50° field of view.
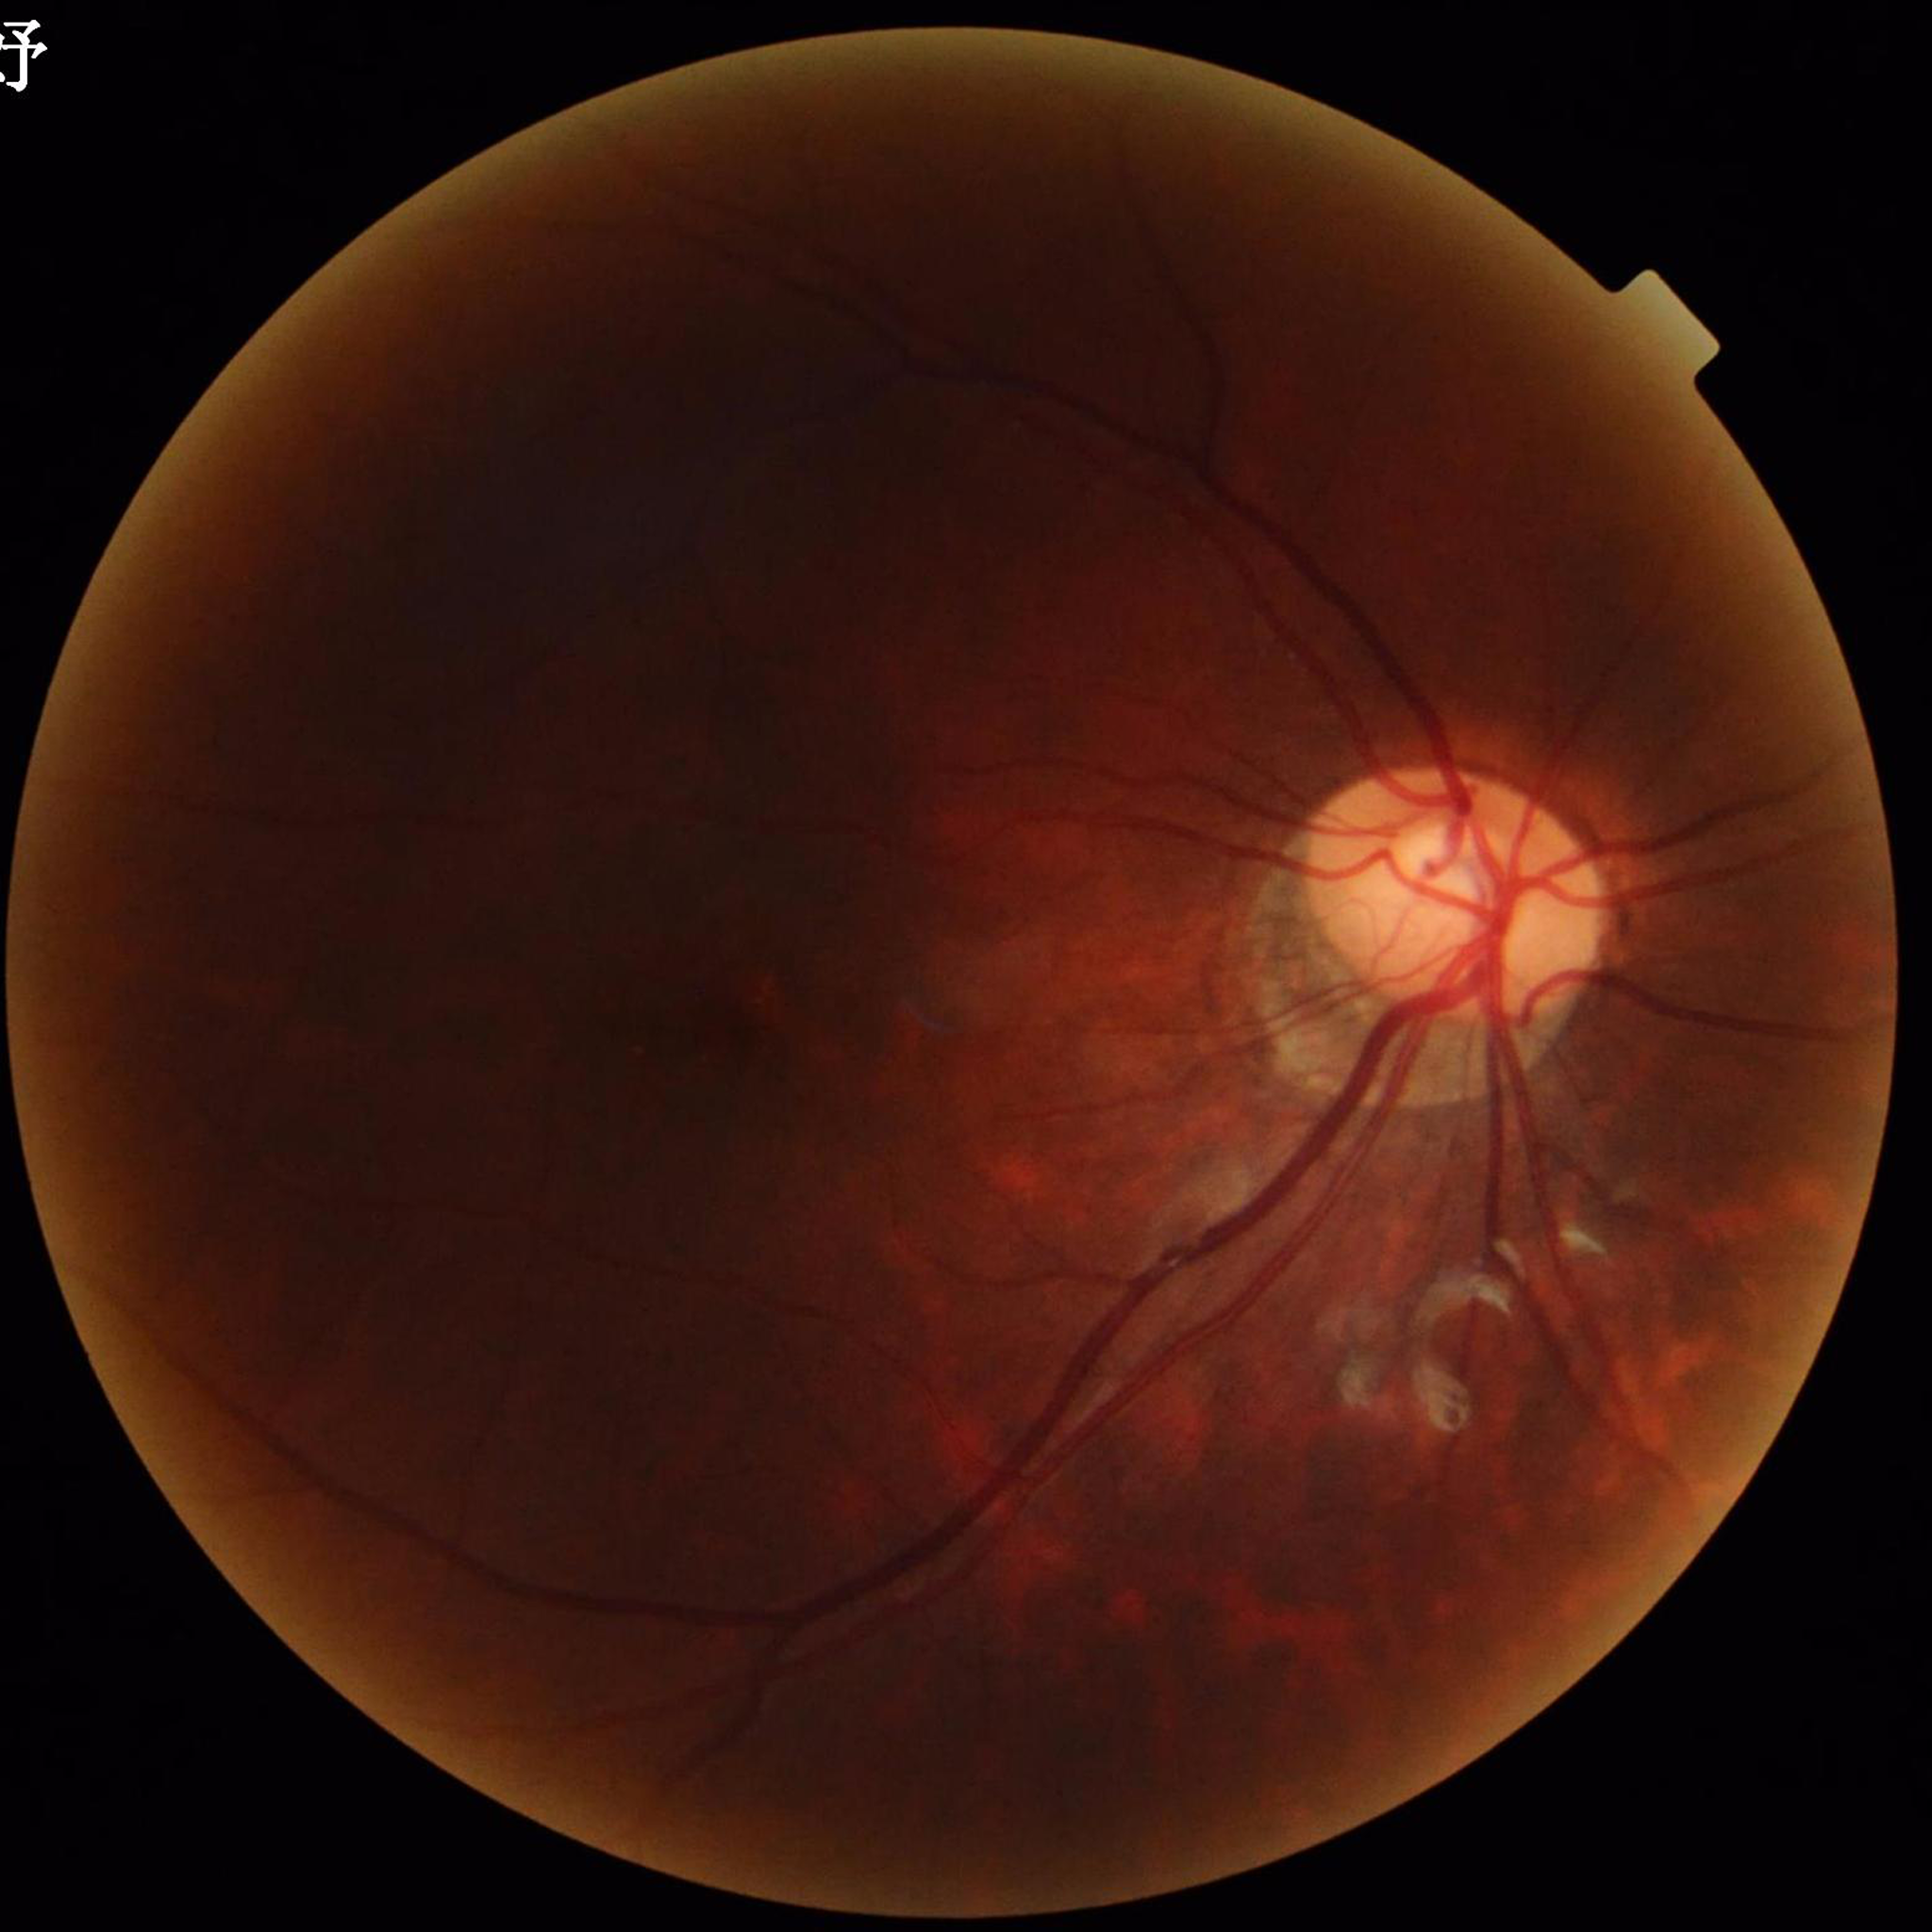 Fundus image with no AMD, diabetic retinopathy, or glaucomatous findings.